Without pupil dilation, 45-degree field of view — 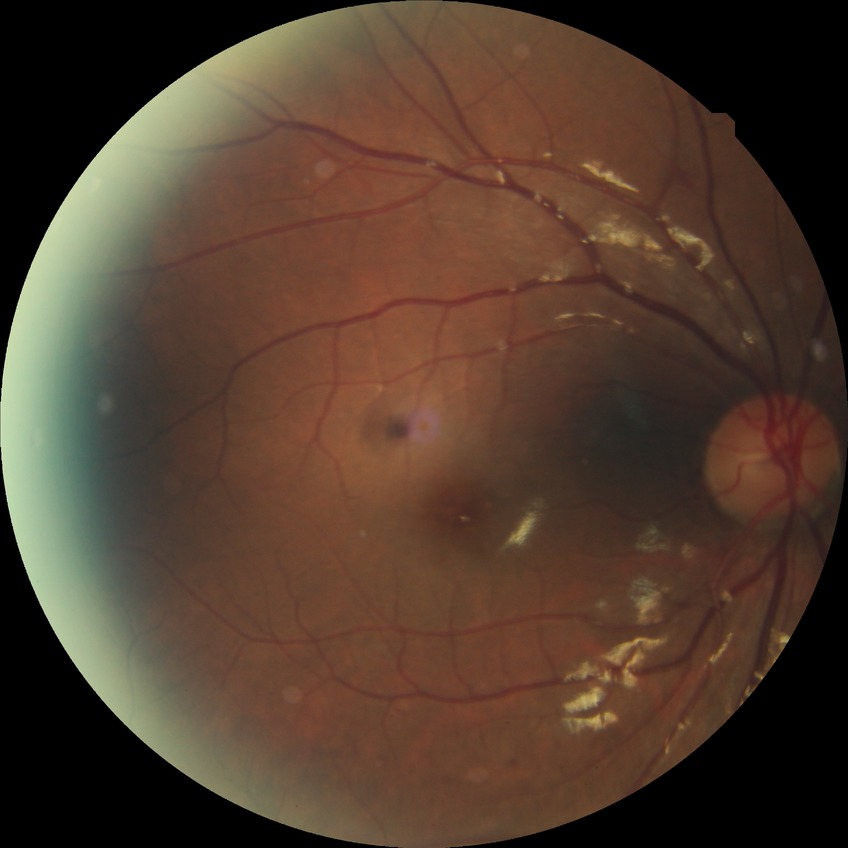

Diabetic retinopathy (DR): SDR (simple diabetic retinopathy).